Captured without pupil dilation. Image size 240x240.
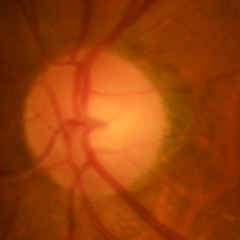

Q: Does this eye have glaucoma?
A: No glaucoma.